Wide-field contact fundus photograph of an infant; 640x480; acquired on the Clarity RetCam 3: 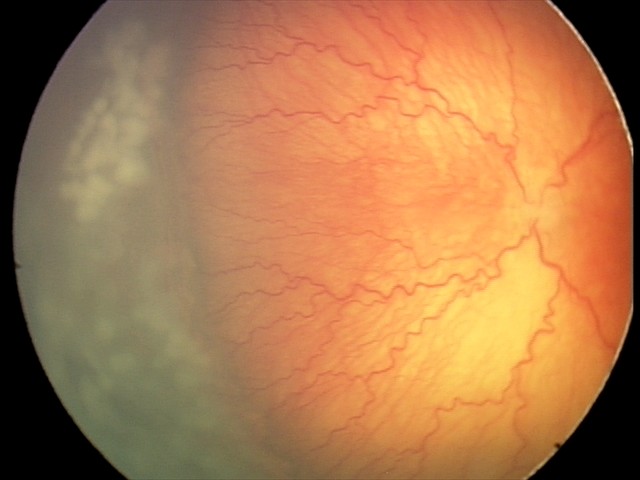
Plus disease present. Series diagnosed as aggressive retinopathy of prematurity.